FOV: 45 degrees: 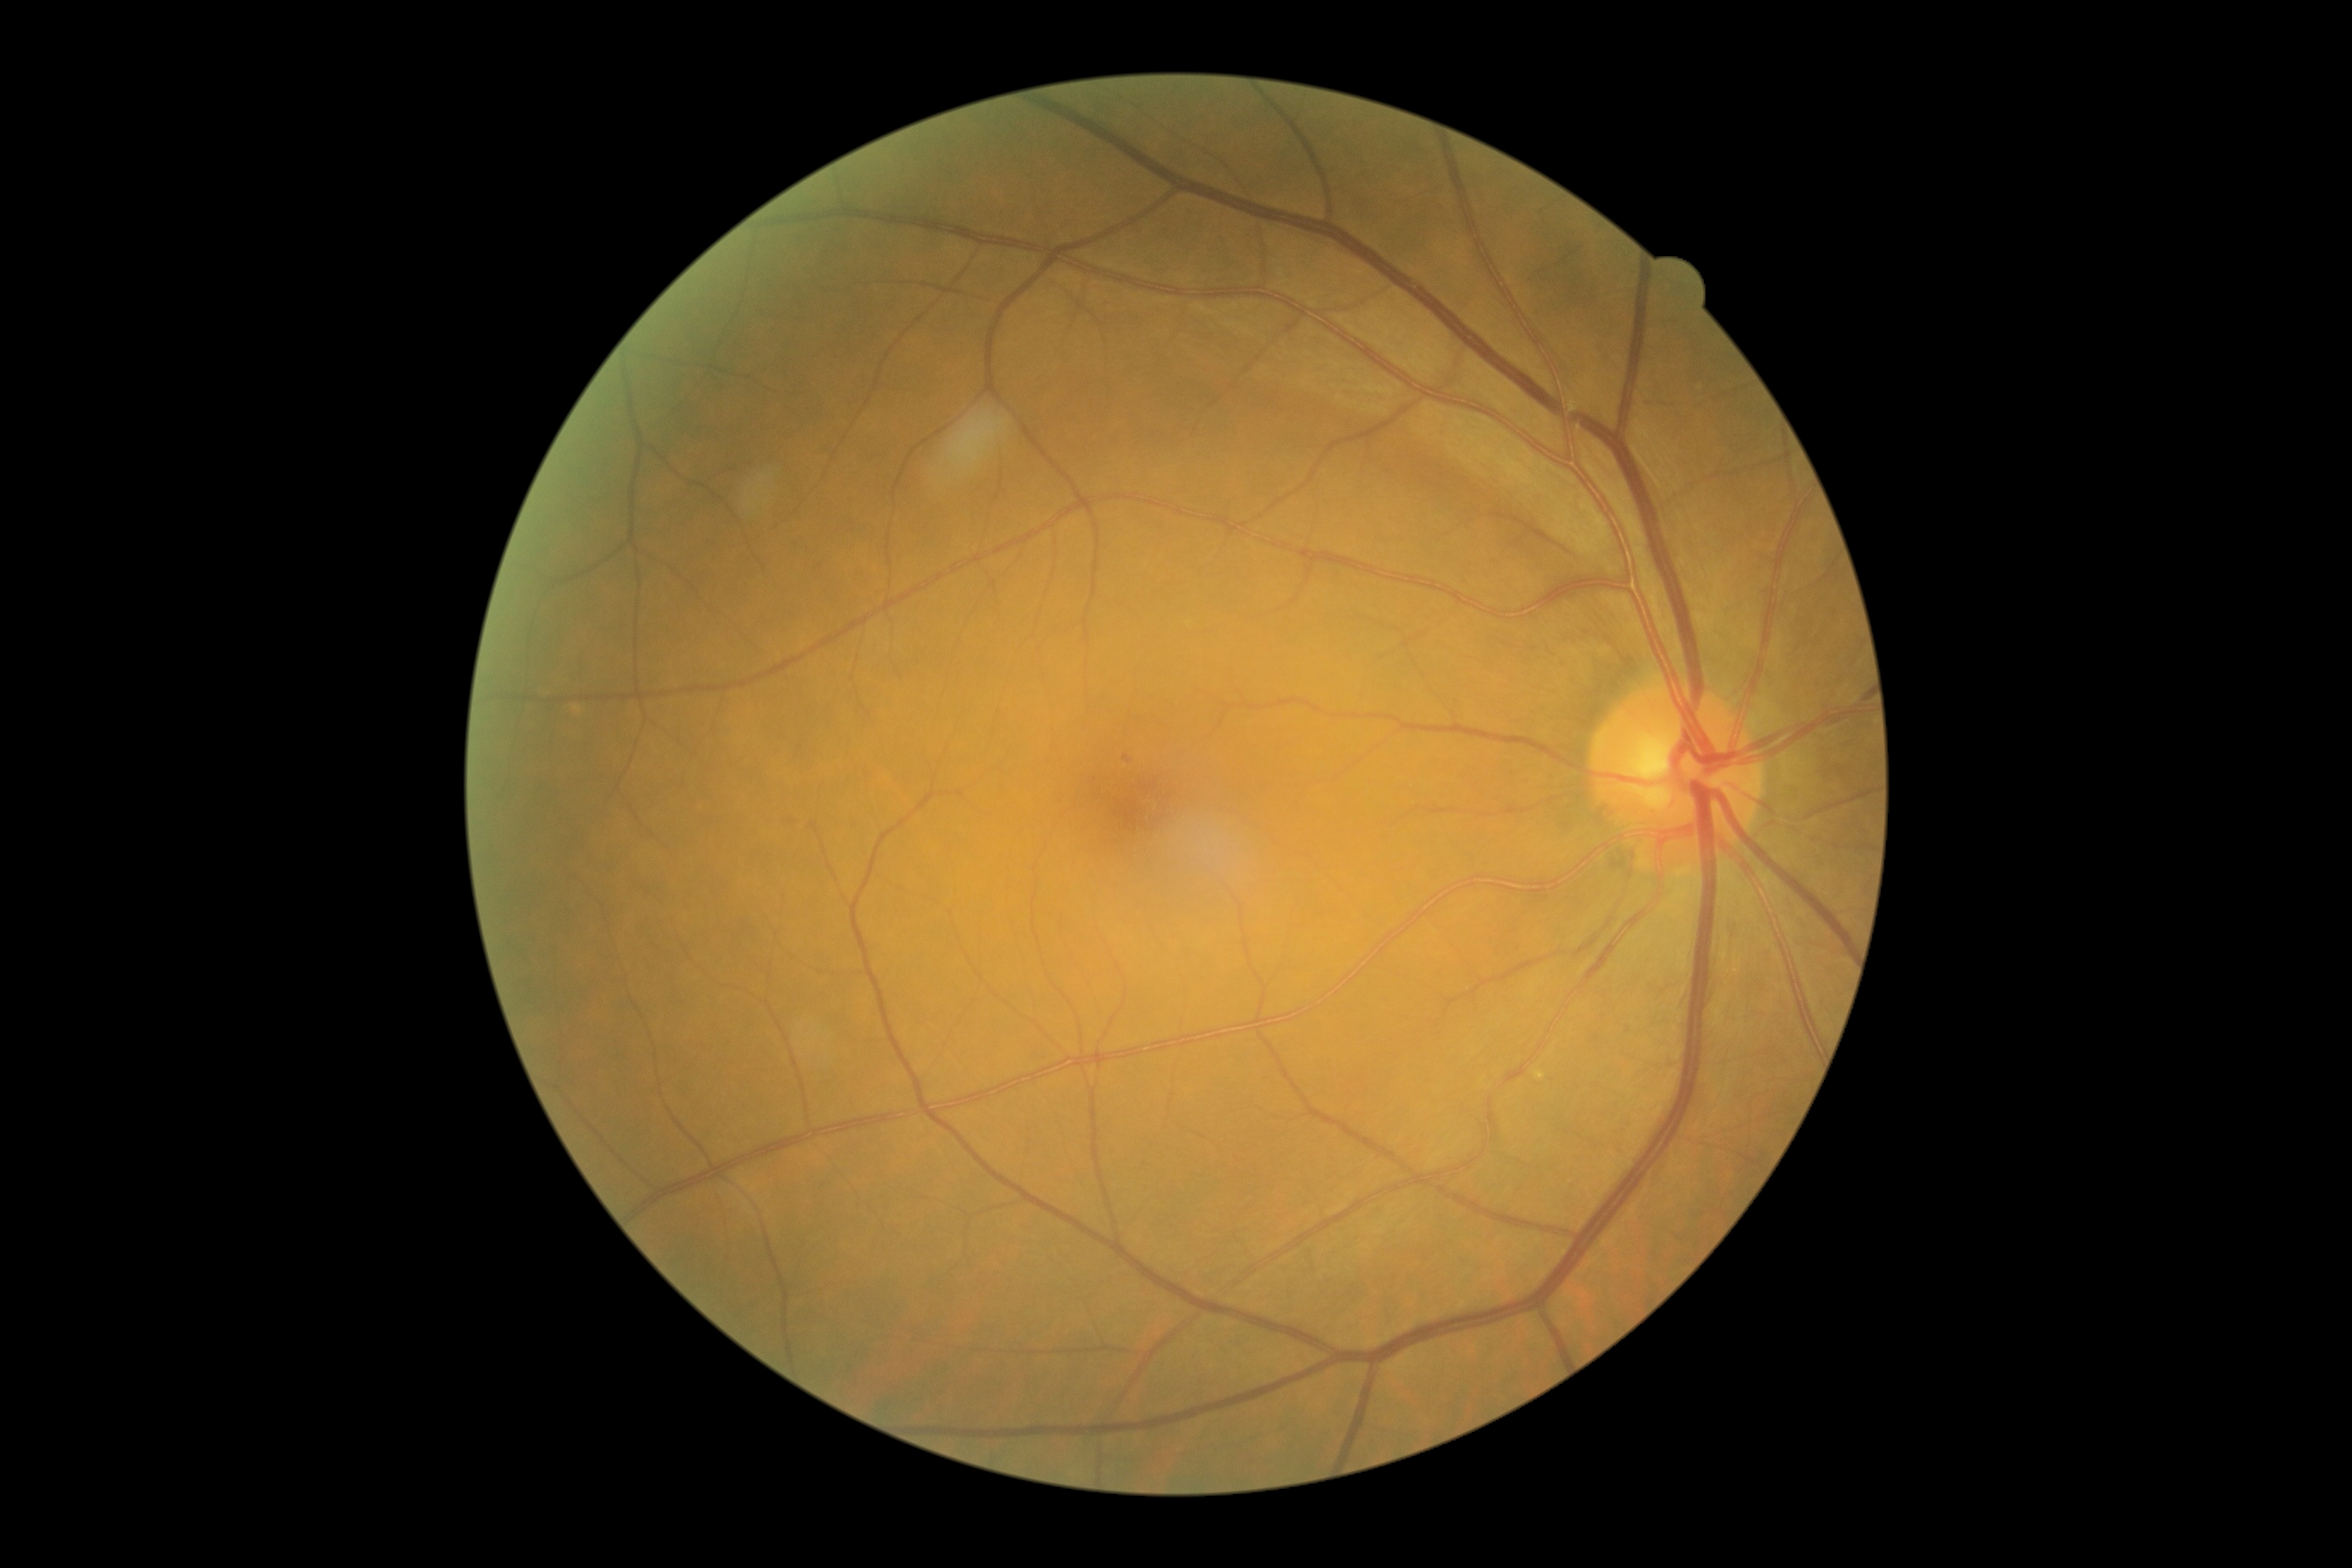
DR is mild NPDR (grade 1) — presence of microaneurysms only.